640x480px; RetCam wide-field infant fundus image
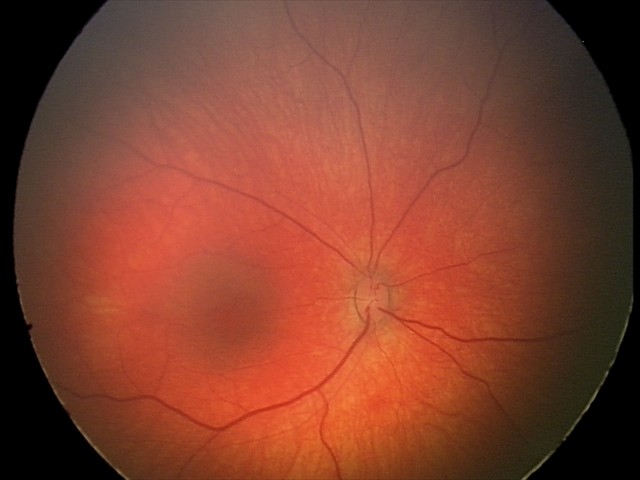

Screening examination diagnosed as physiological.